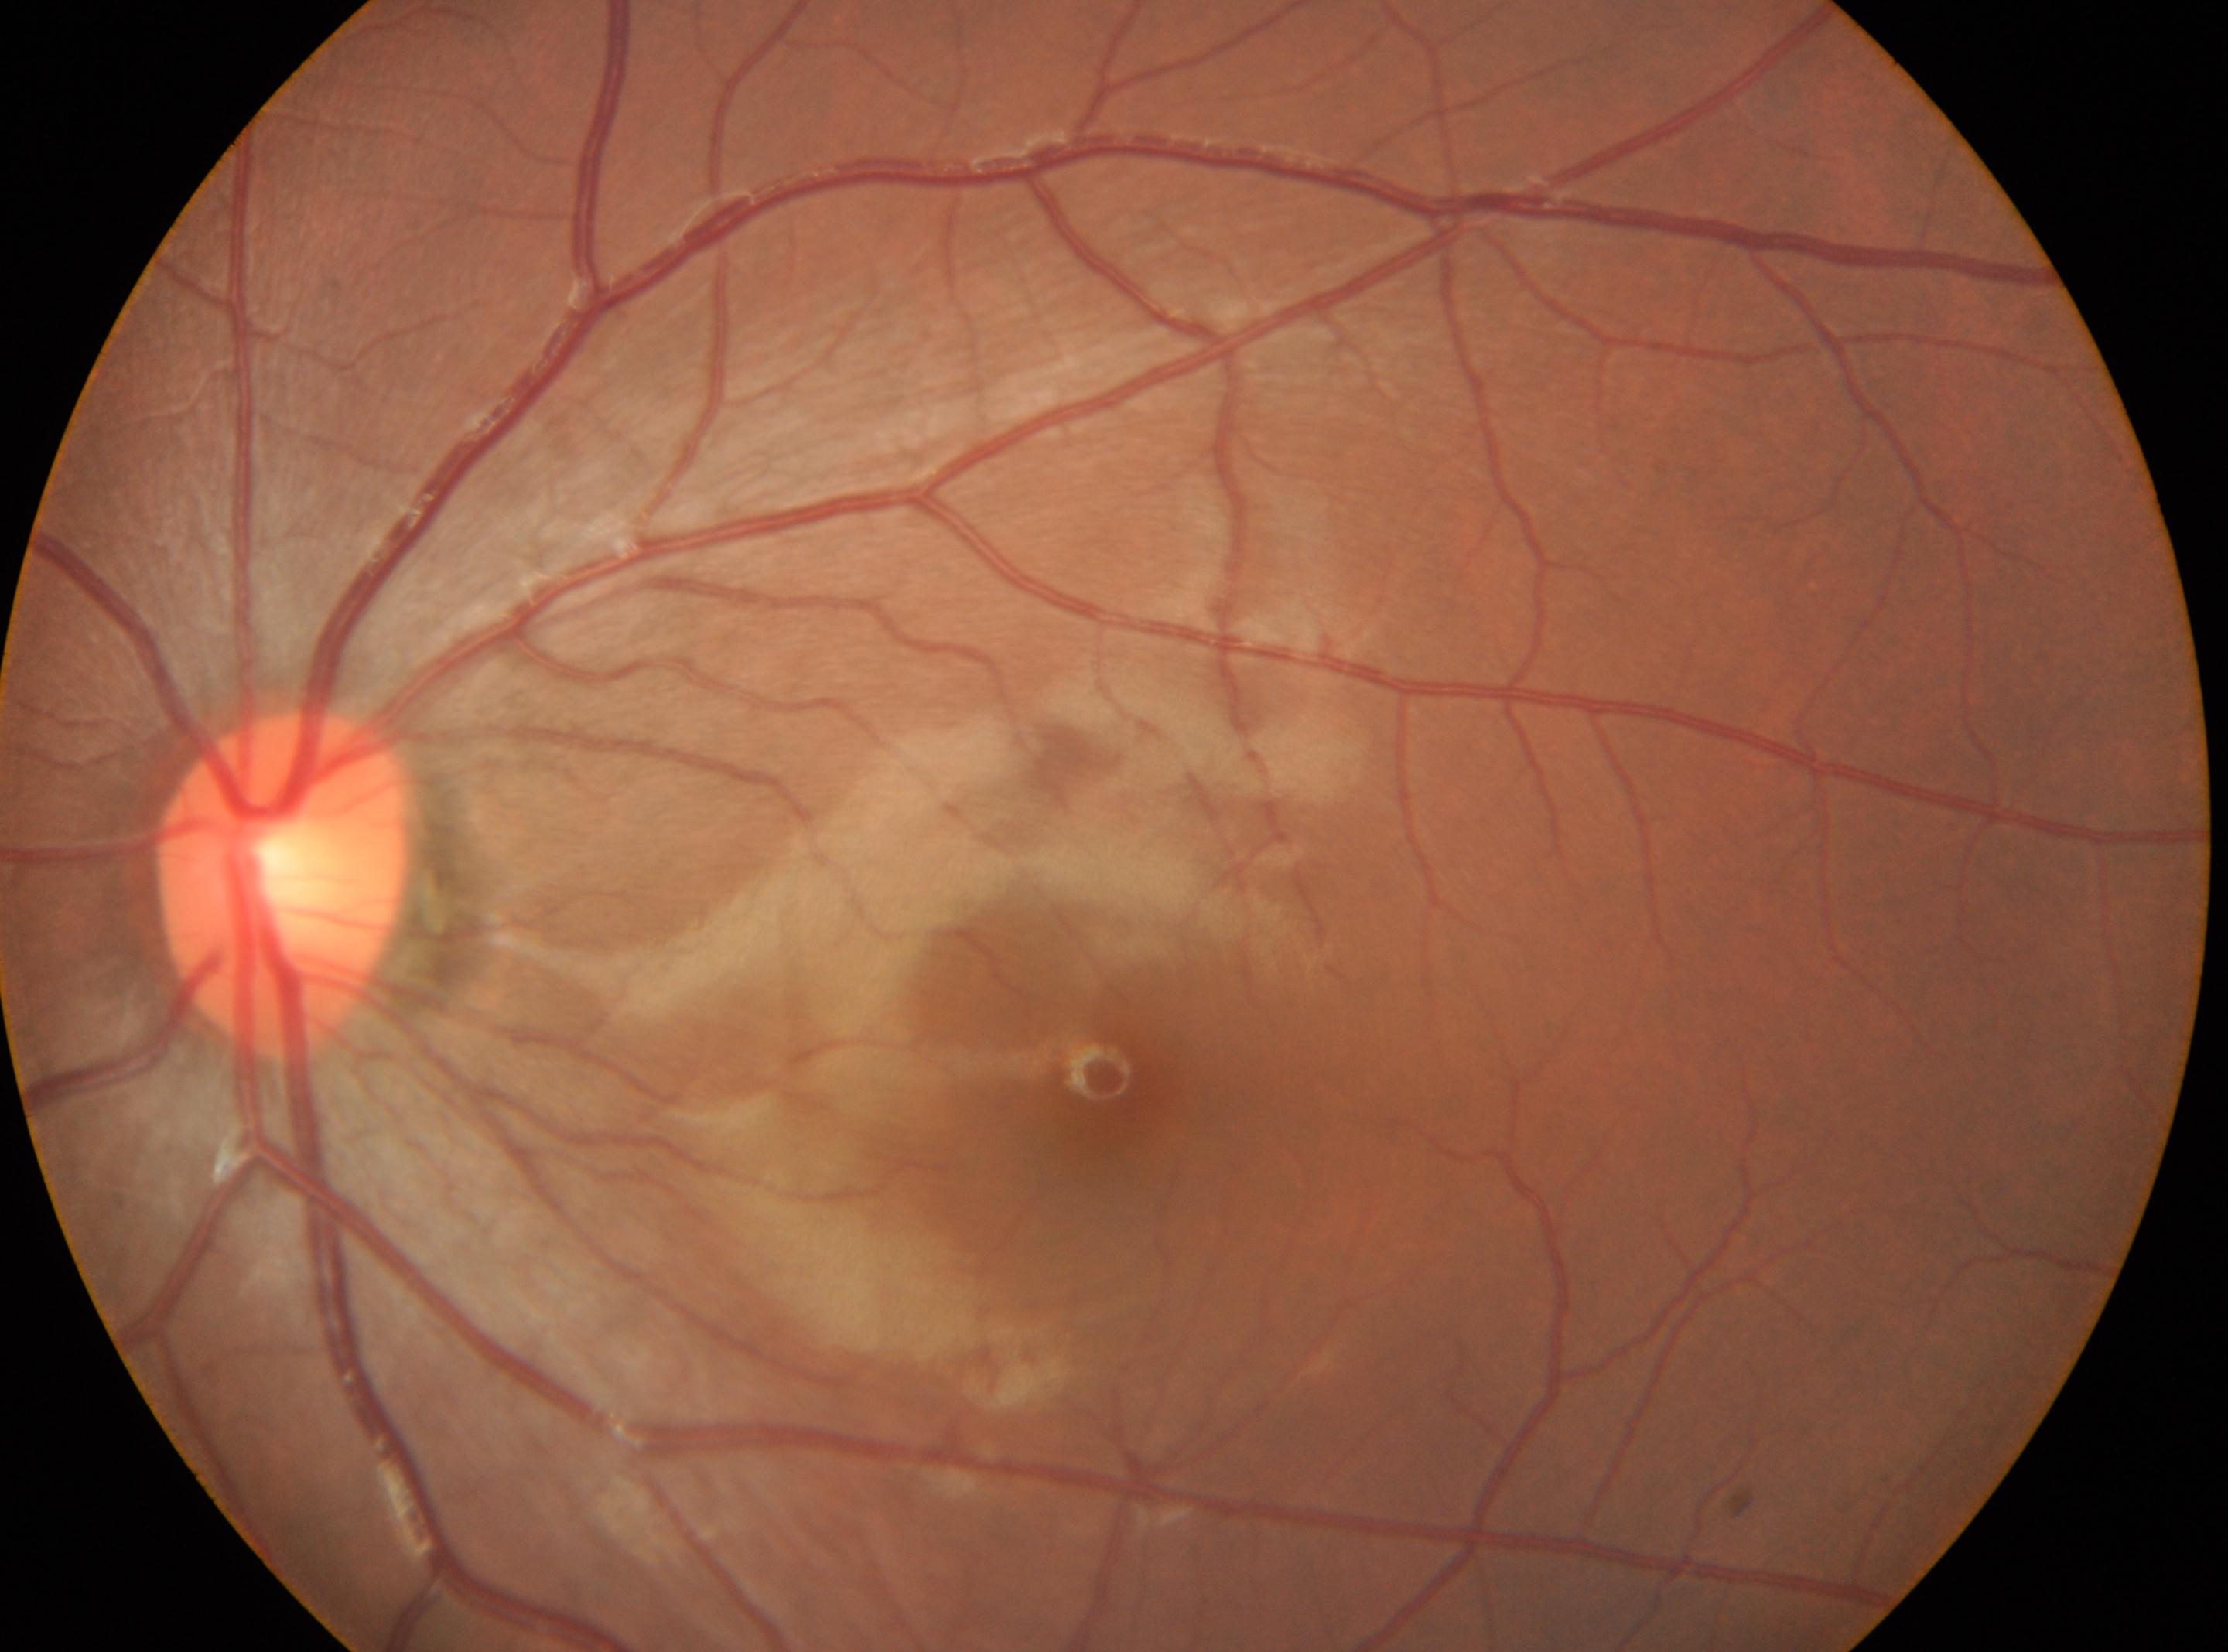
laterality: the left eye; DR impression: No diabetic retinal disease findings; fovea center: (1109,1083); DR stage: grade 0 (no apparent retinopathy); optic nerve head: (284,882).